512 by 512 pixels:
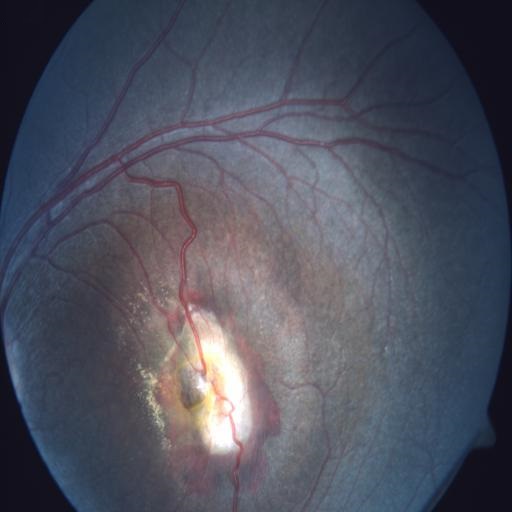
Findings: chorioretinitis.